Color fundus photograph: 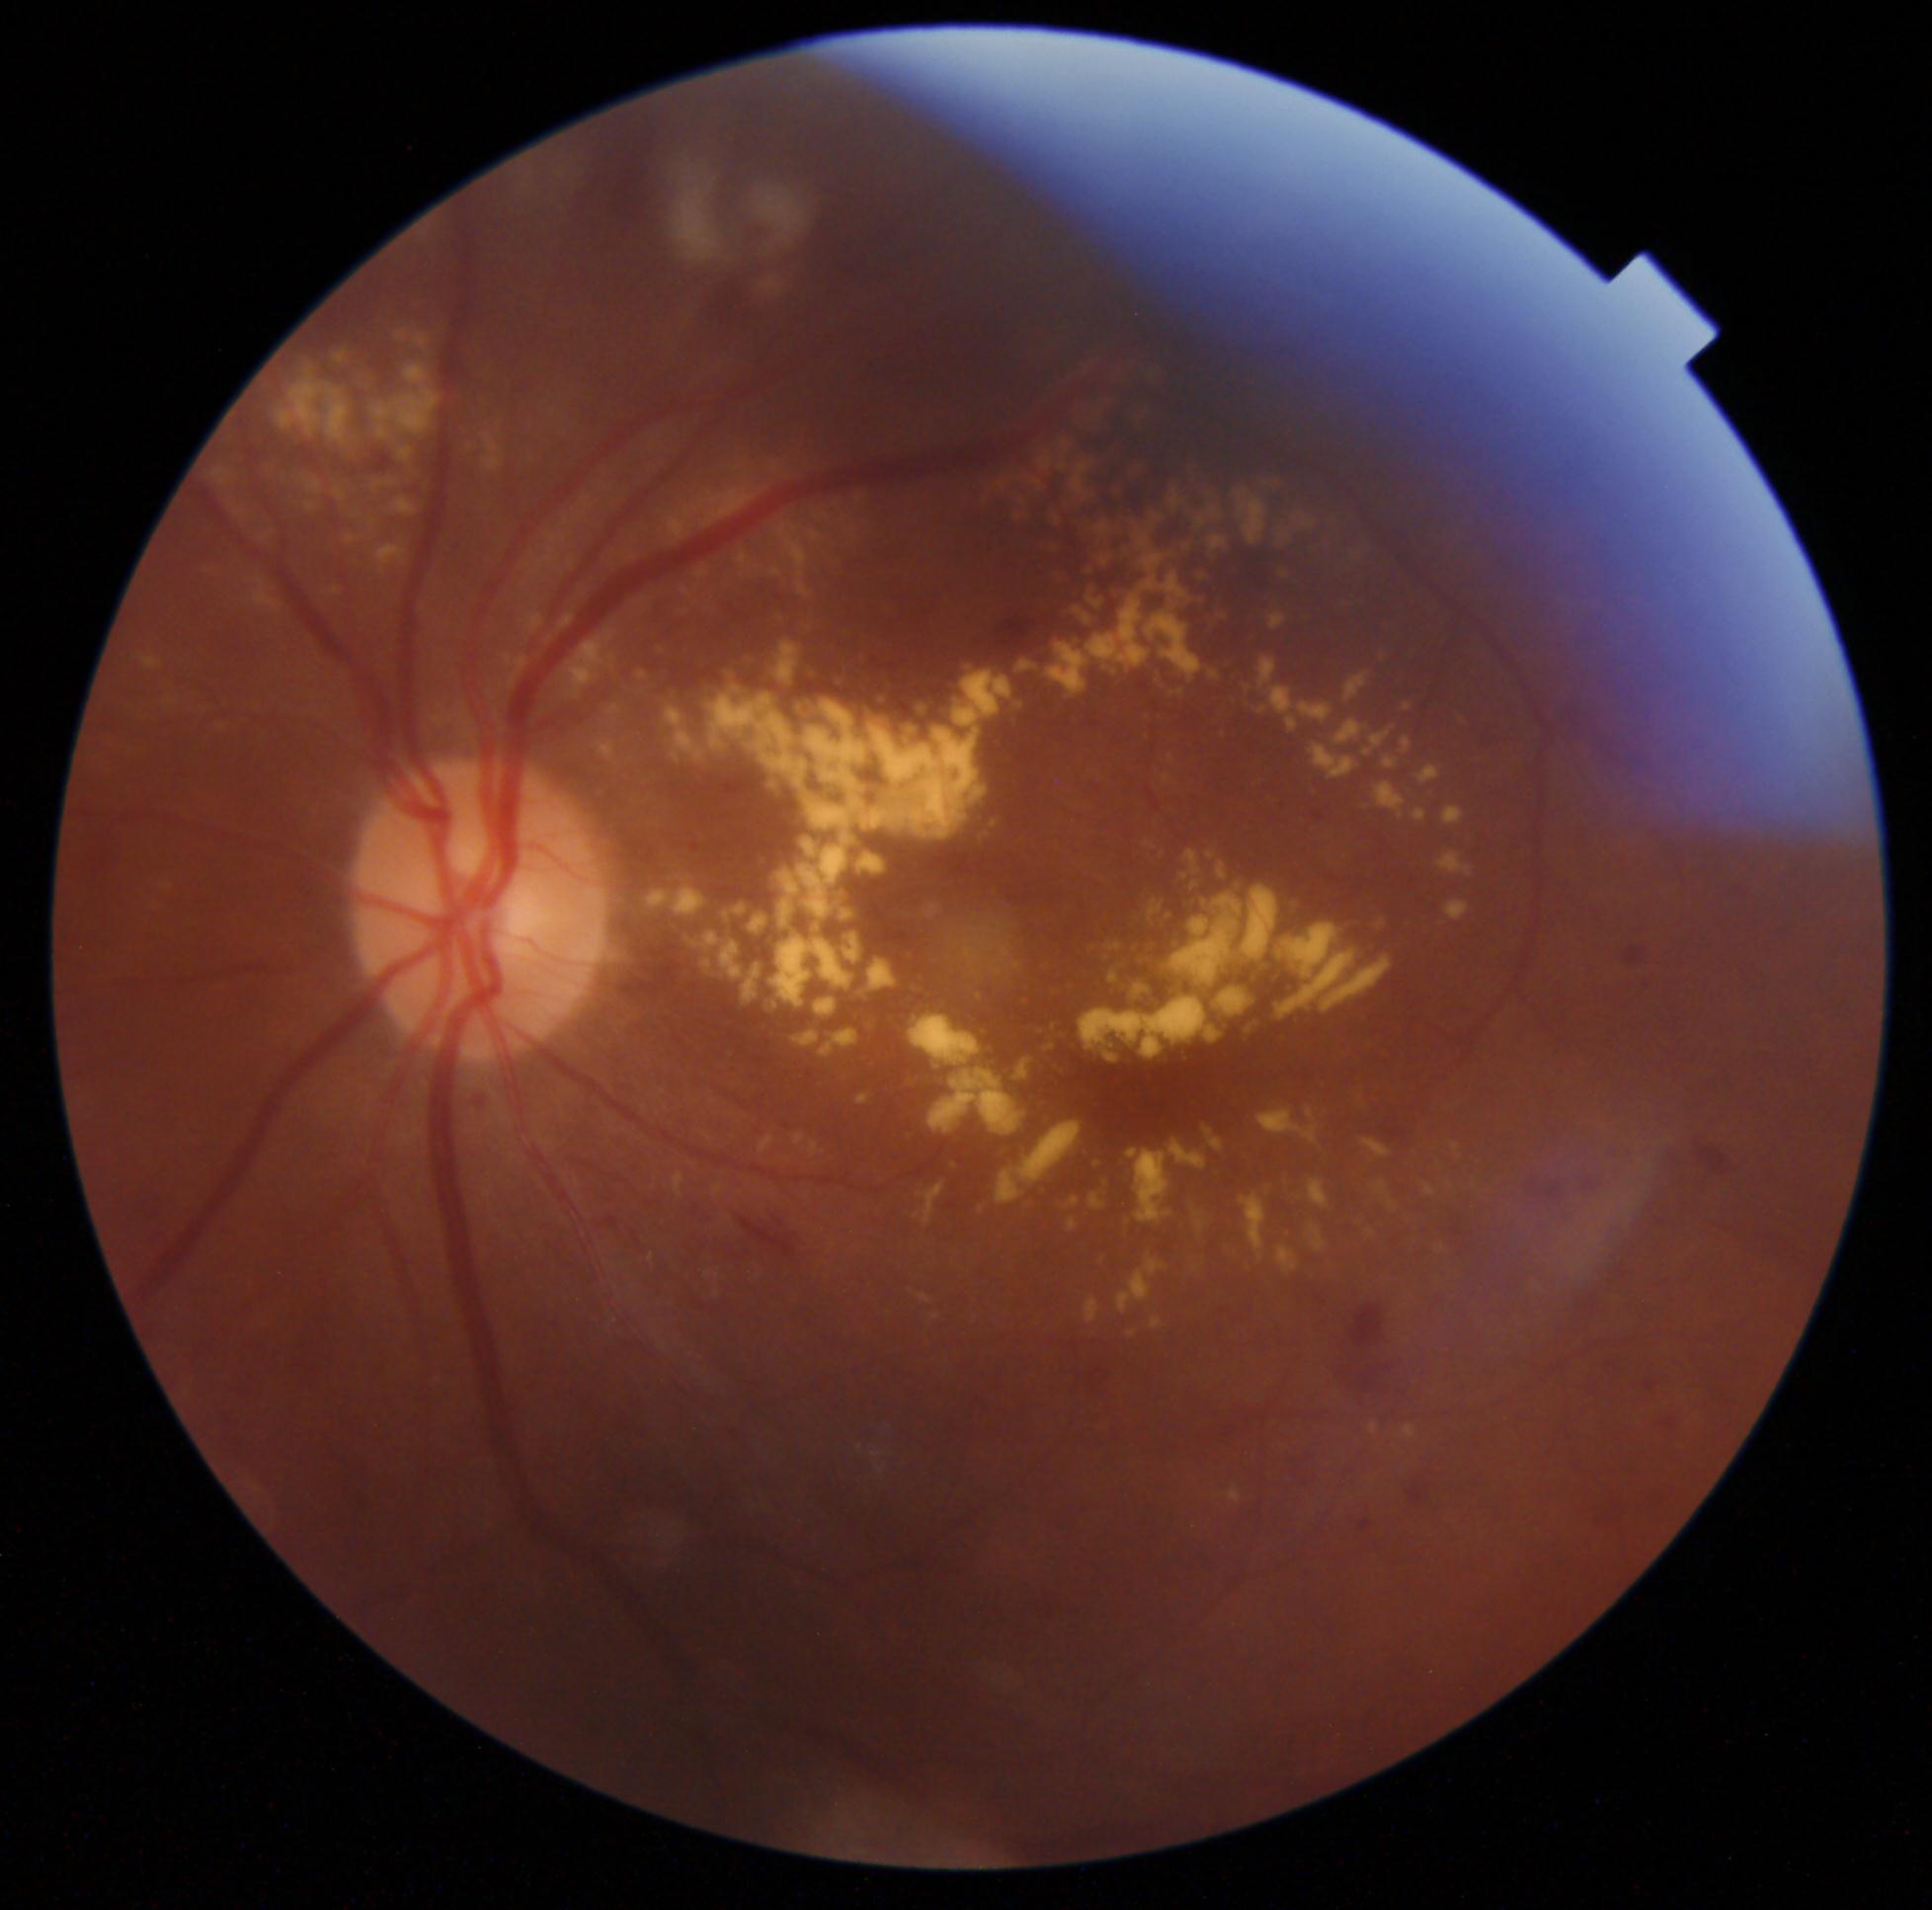
Annotations:
– DR grade: 2 (moderate NPDR) — more than just microaneurysms but less than severe NPDR